Pediatric wide-field fundus photograph · captured with the Clarity RetCam 3 (130° field of view):
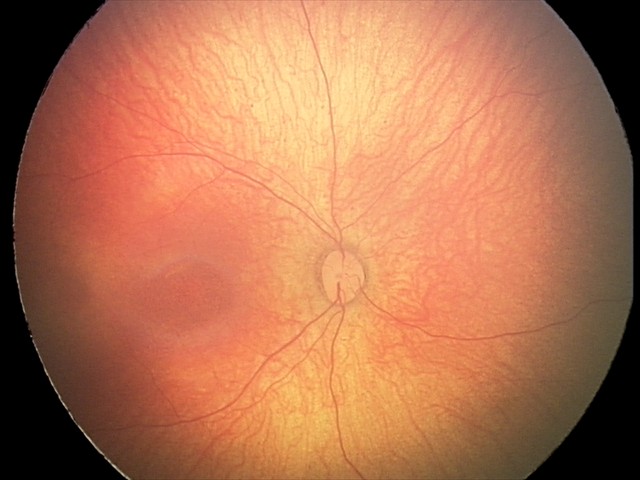

Screening examination with no abnormal retinal findings.